1240 by 1240 pixels; wide-field fundus photograph from neonatal ROP screening.
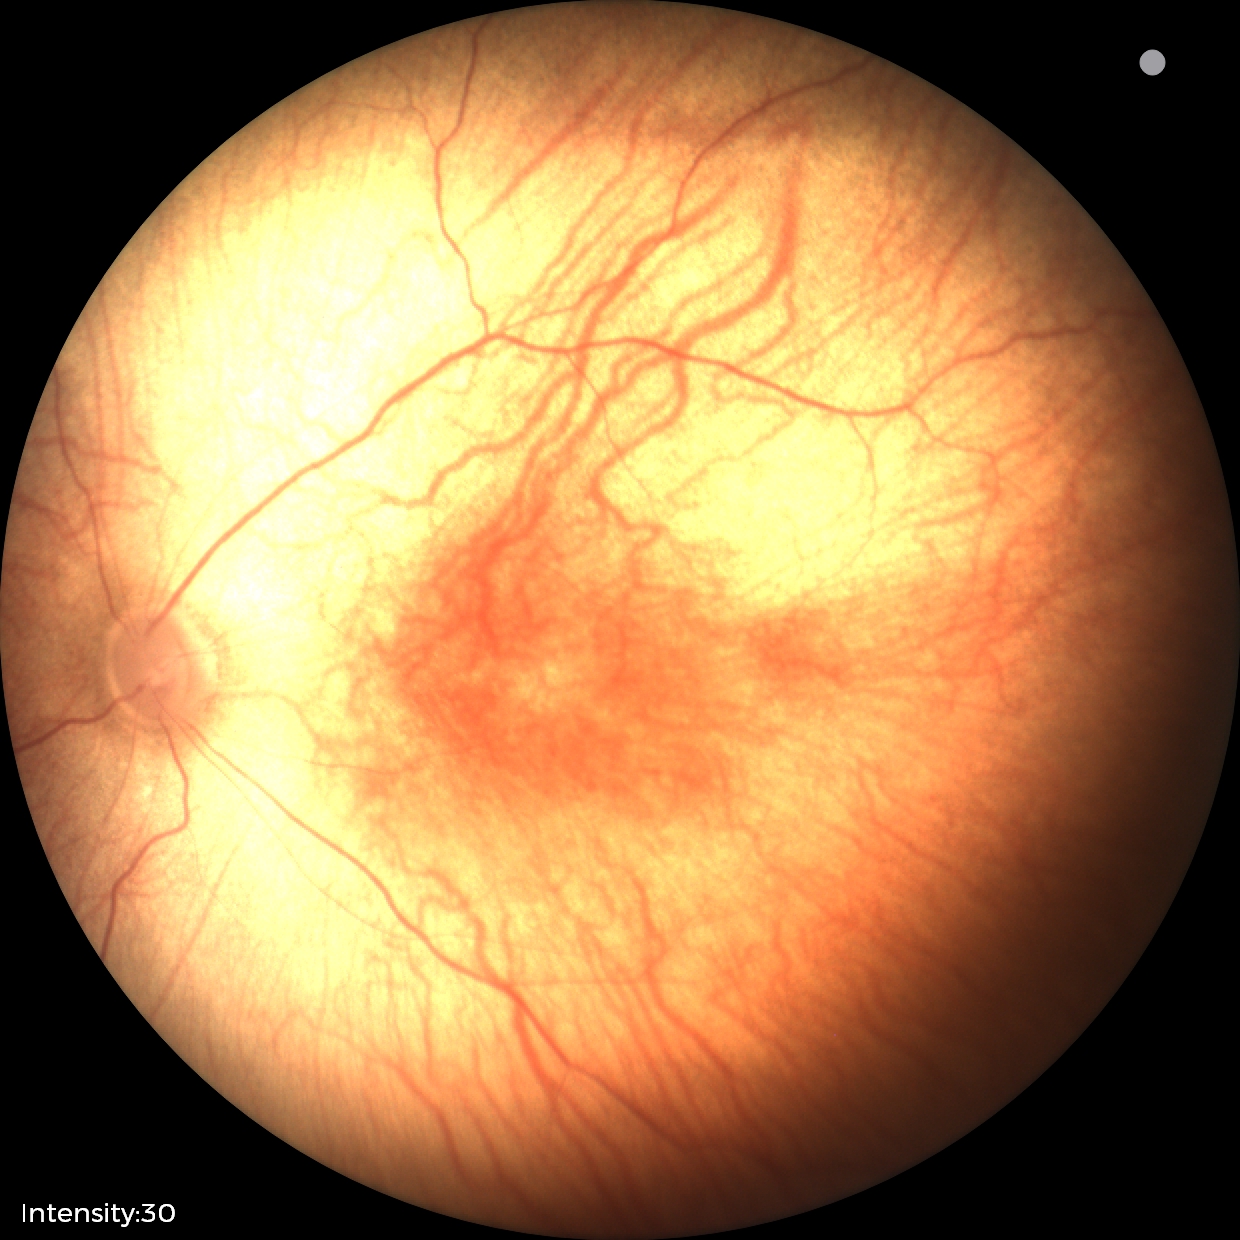 Examination with physiological retinal findings.